2352 by 1568 pixels; CFP.
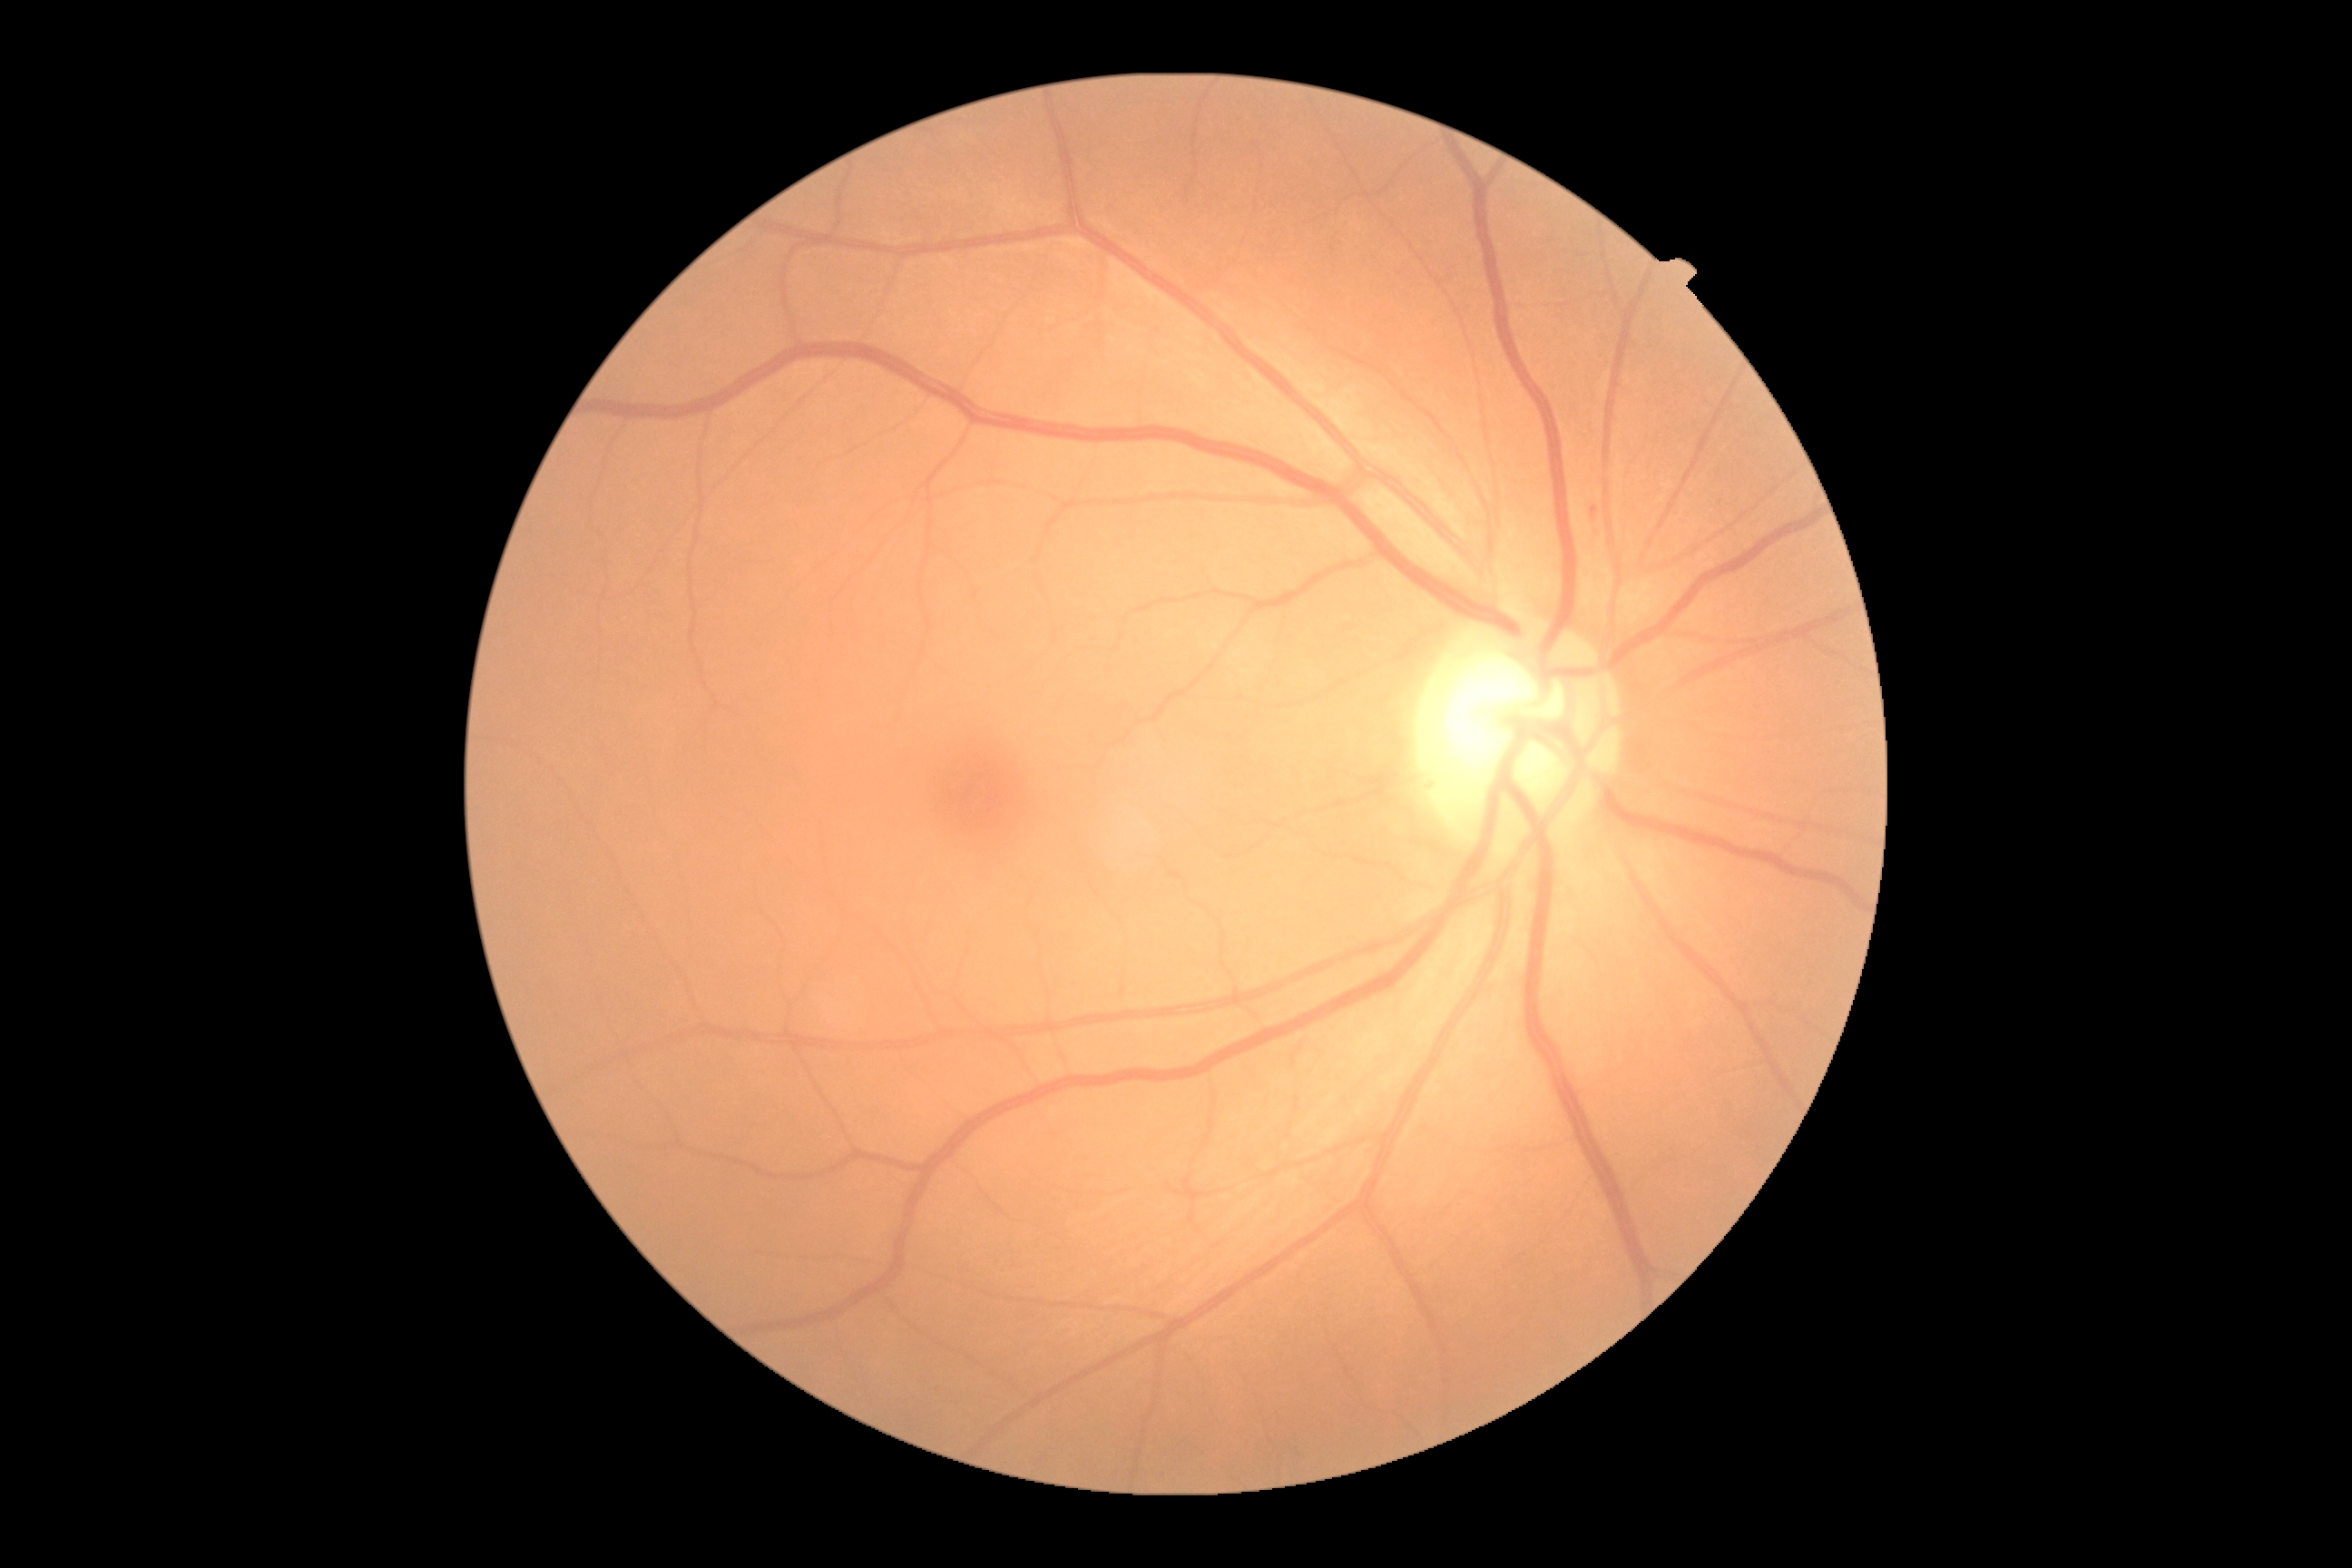 DR severity@2/4; DR class@non-proliferative diabetic retinopathy.